45-degree field of view. 848x848px
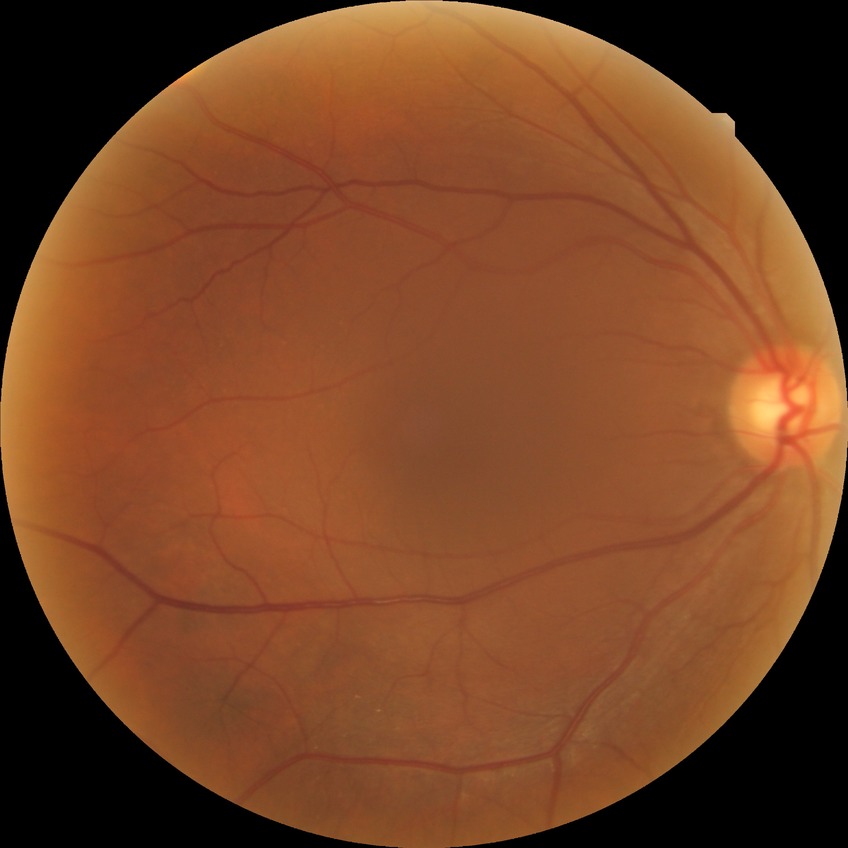

diabetic retinopathy (DR): NDR (no diabetic retinopathy).